DR severity per modified Davis staging, 45-degree field of view, without pupil dilation, NIDEK AFC-230, fundus photo — 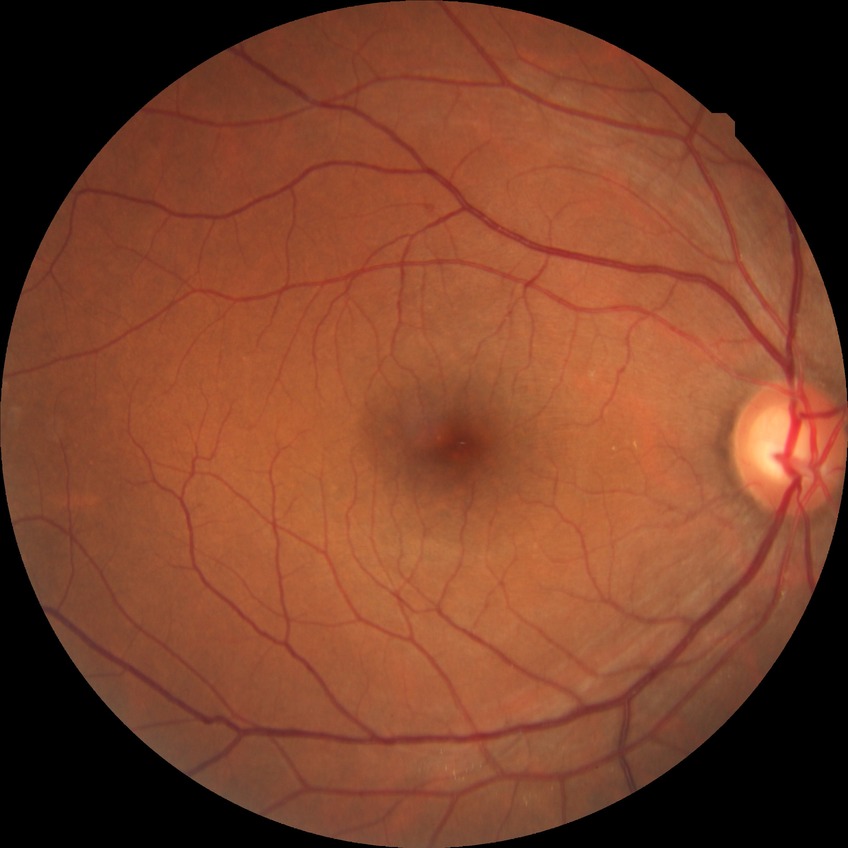

Diabetic retinopathy (DR) is NDR (no diabetic retinopathy).